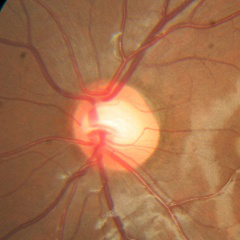 Glaucoma diagnosis: no glaucomatous findings.